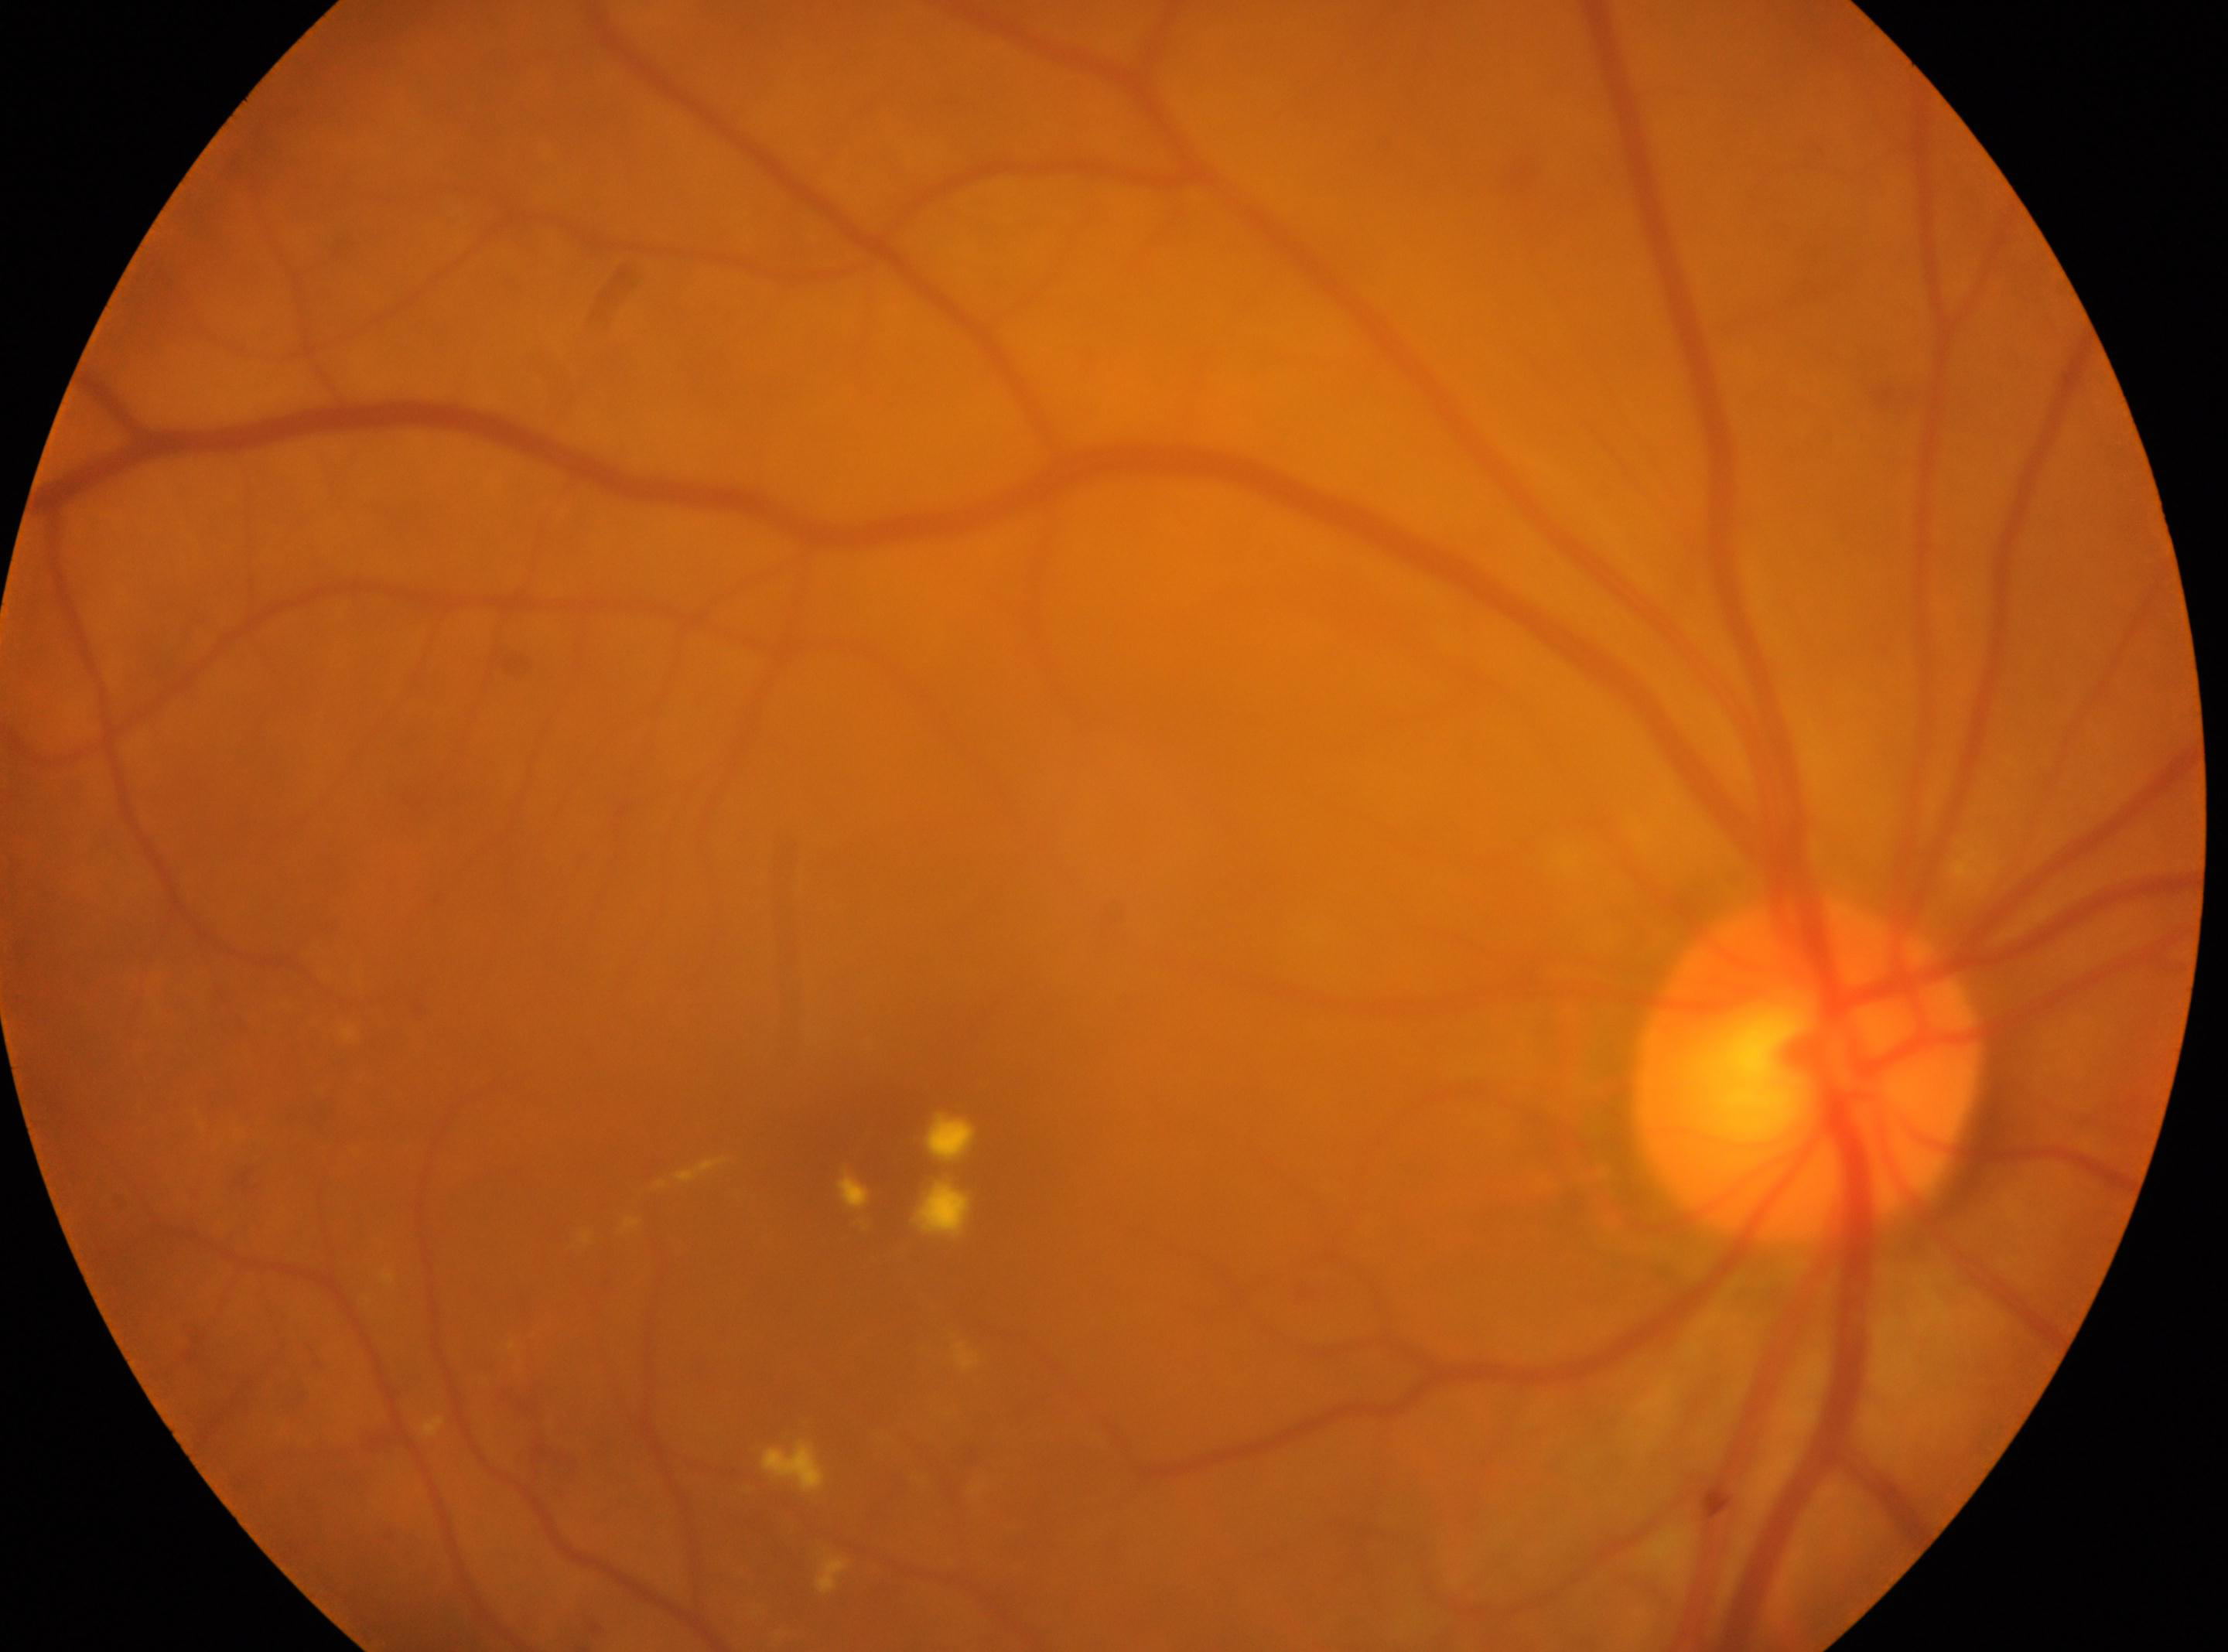

DR stage: moderate NPDR (grade 2) — more than just microaneurysms but less than severe NPDR.
Fovea center: 902, 1160.
Eye: right.
Optic disc: 1806, 1072.